Davis DR grading, nonmydriatic
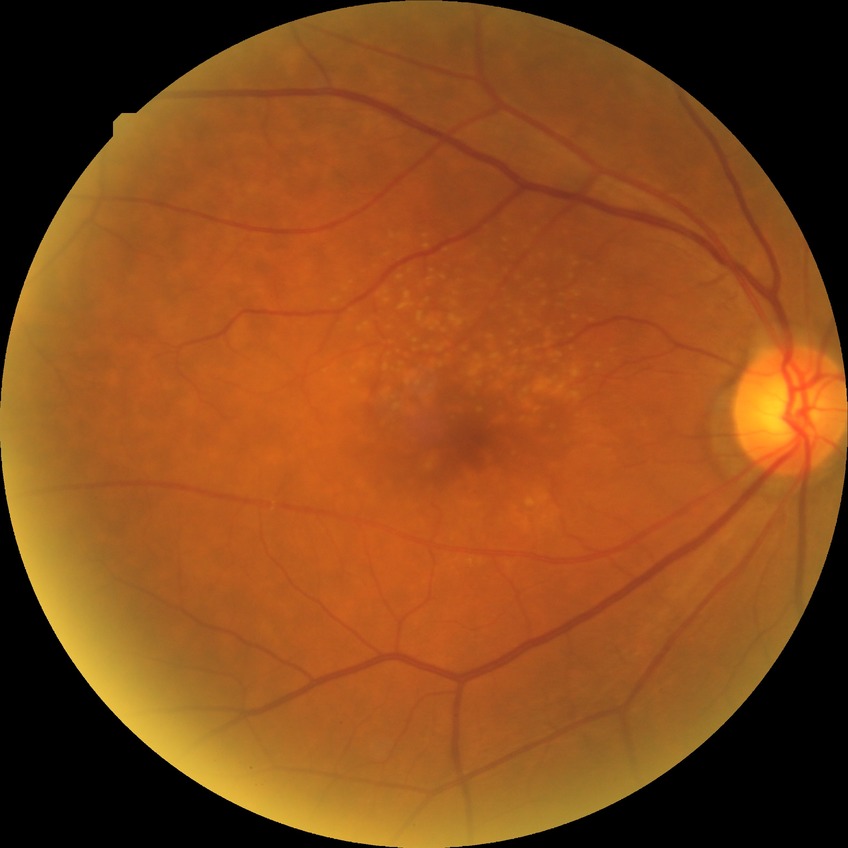 Assessment:
- diabetic retinopathy stage — no diabetic retinopathy